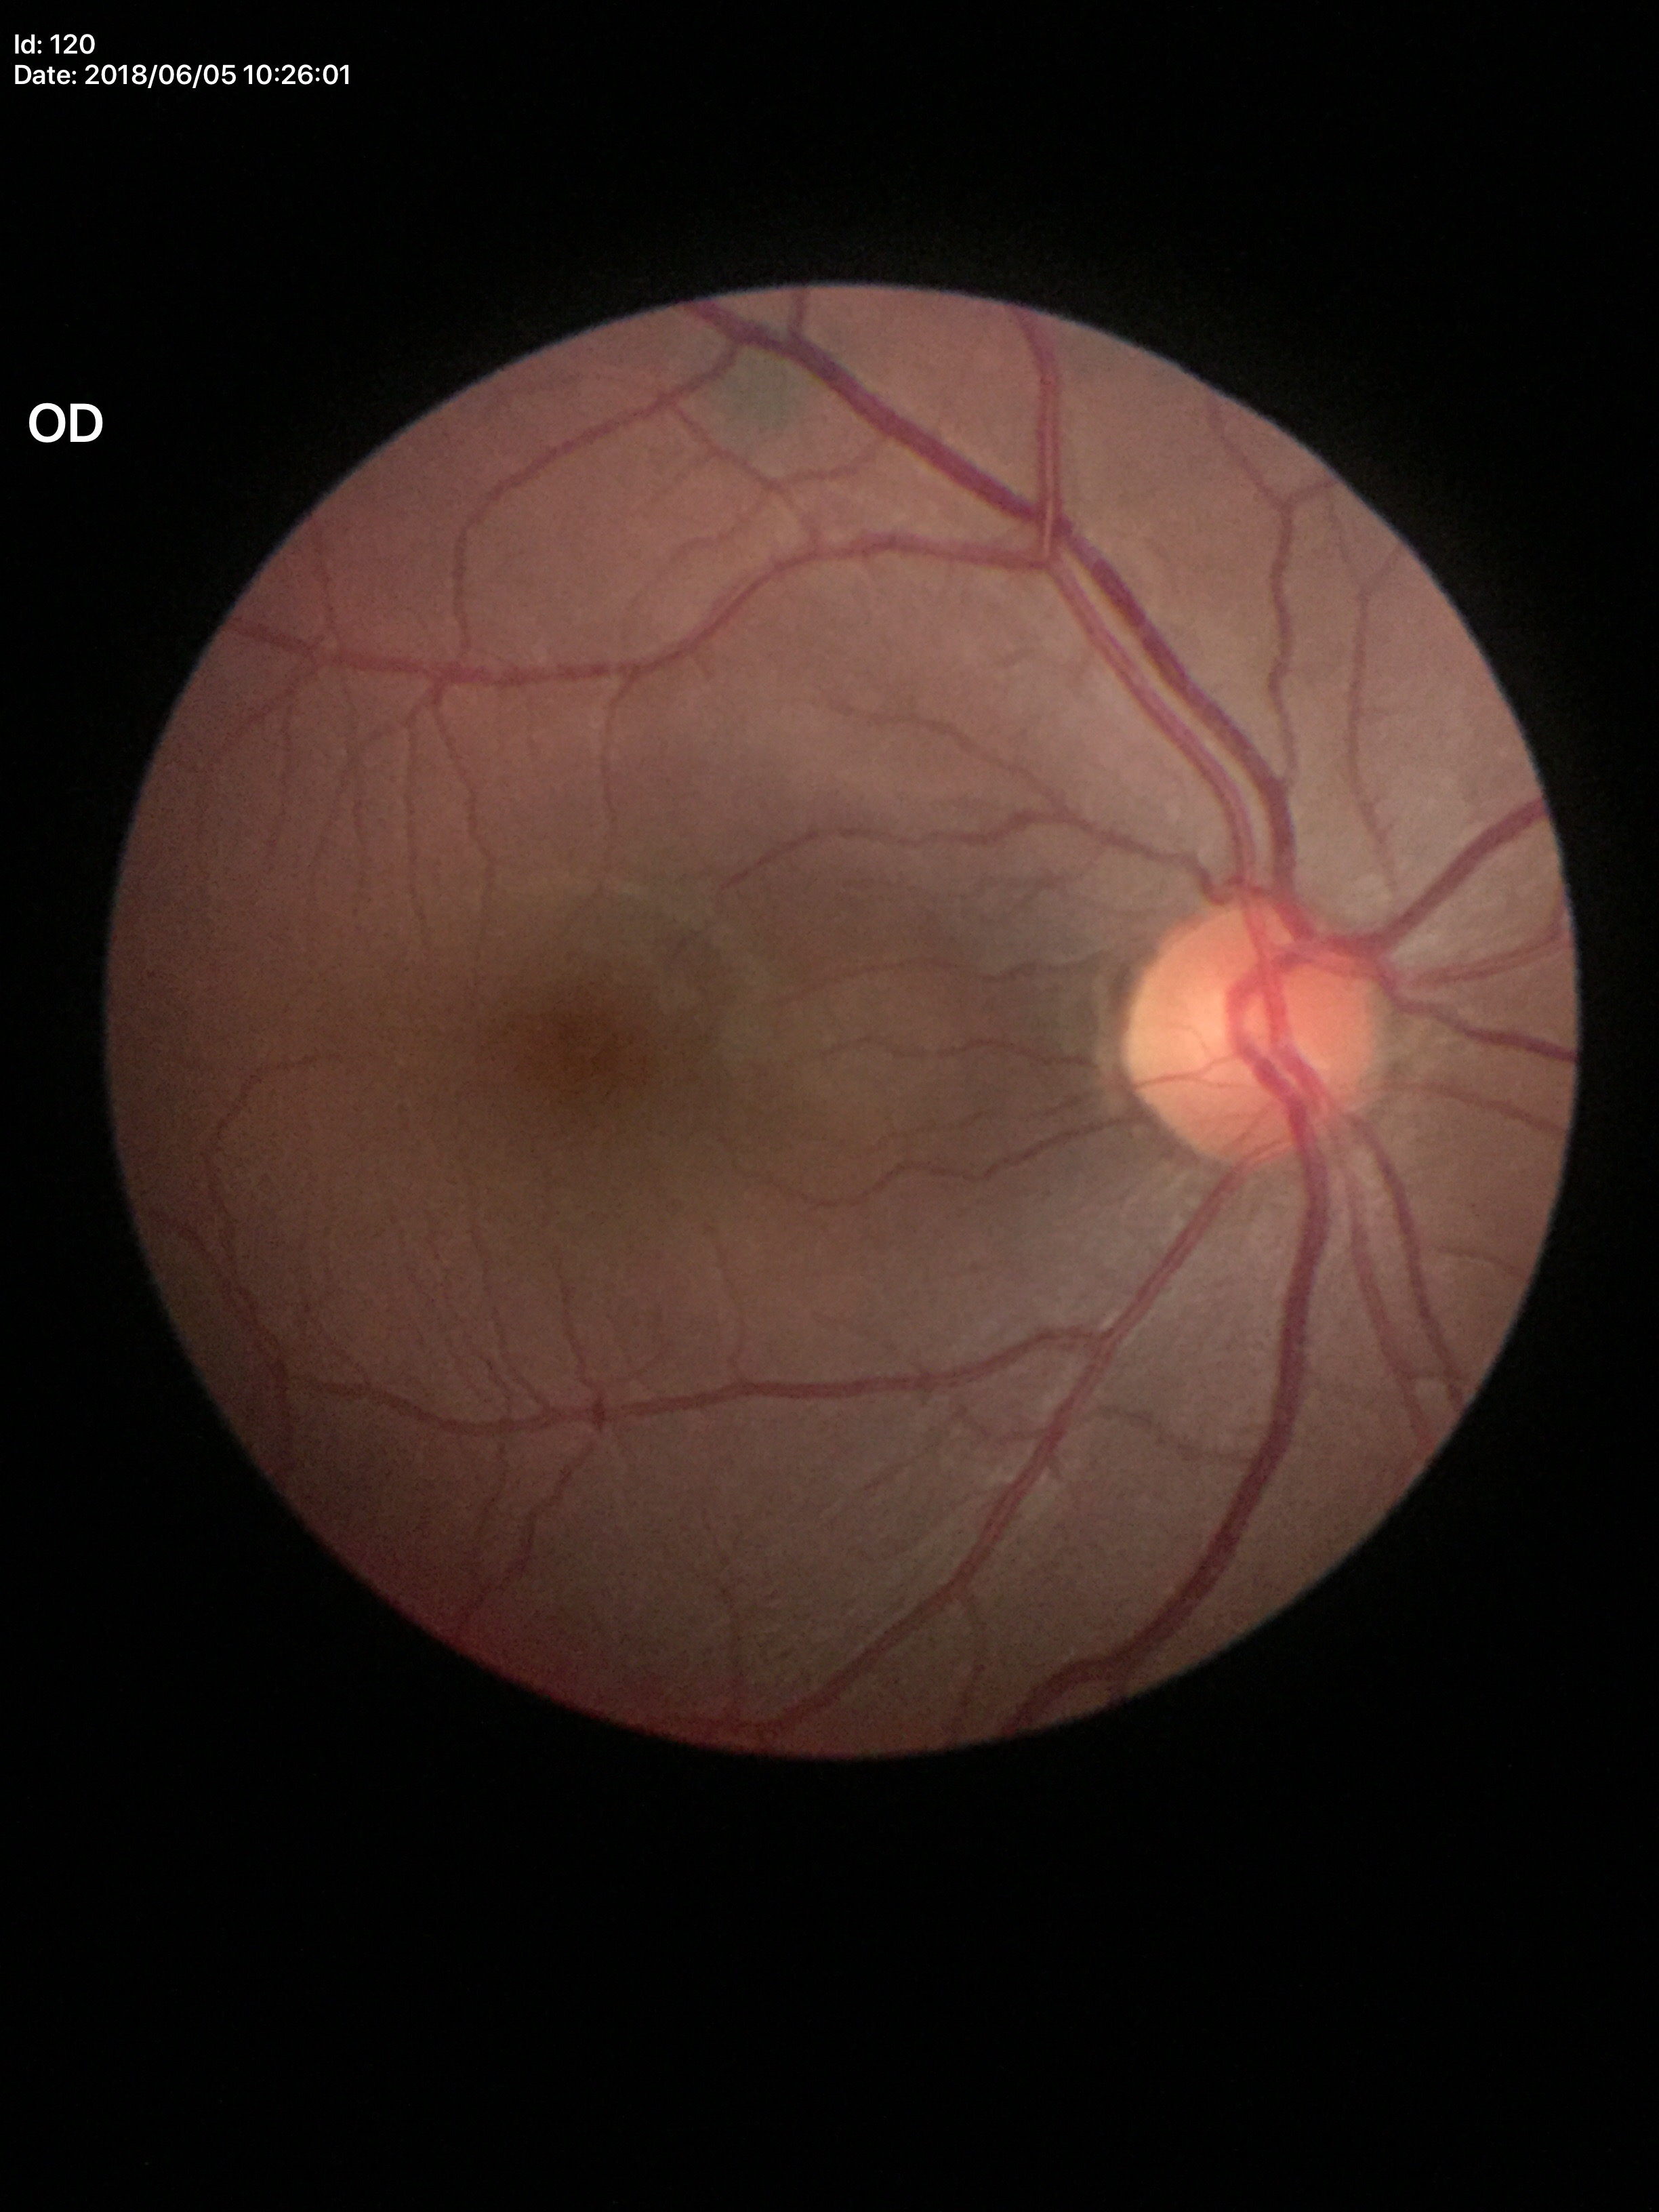

Glaucoma screening = no suspicious findings (unanimous normal call) | vertical cup-to-disc ratio = 0.47.